Image size 2212x1659; 45° FOV; CFP:
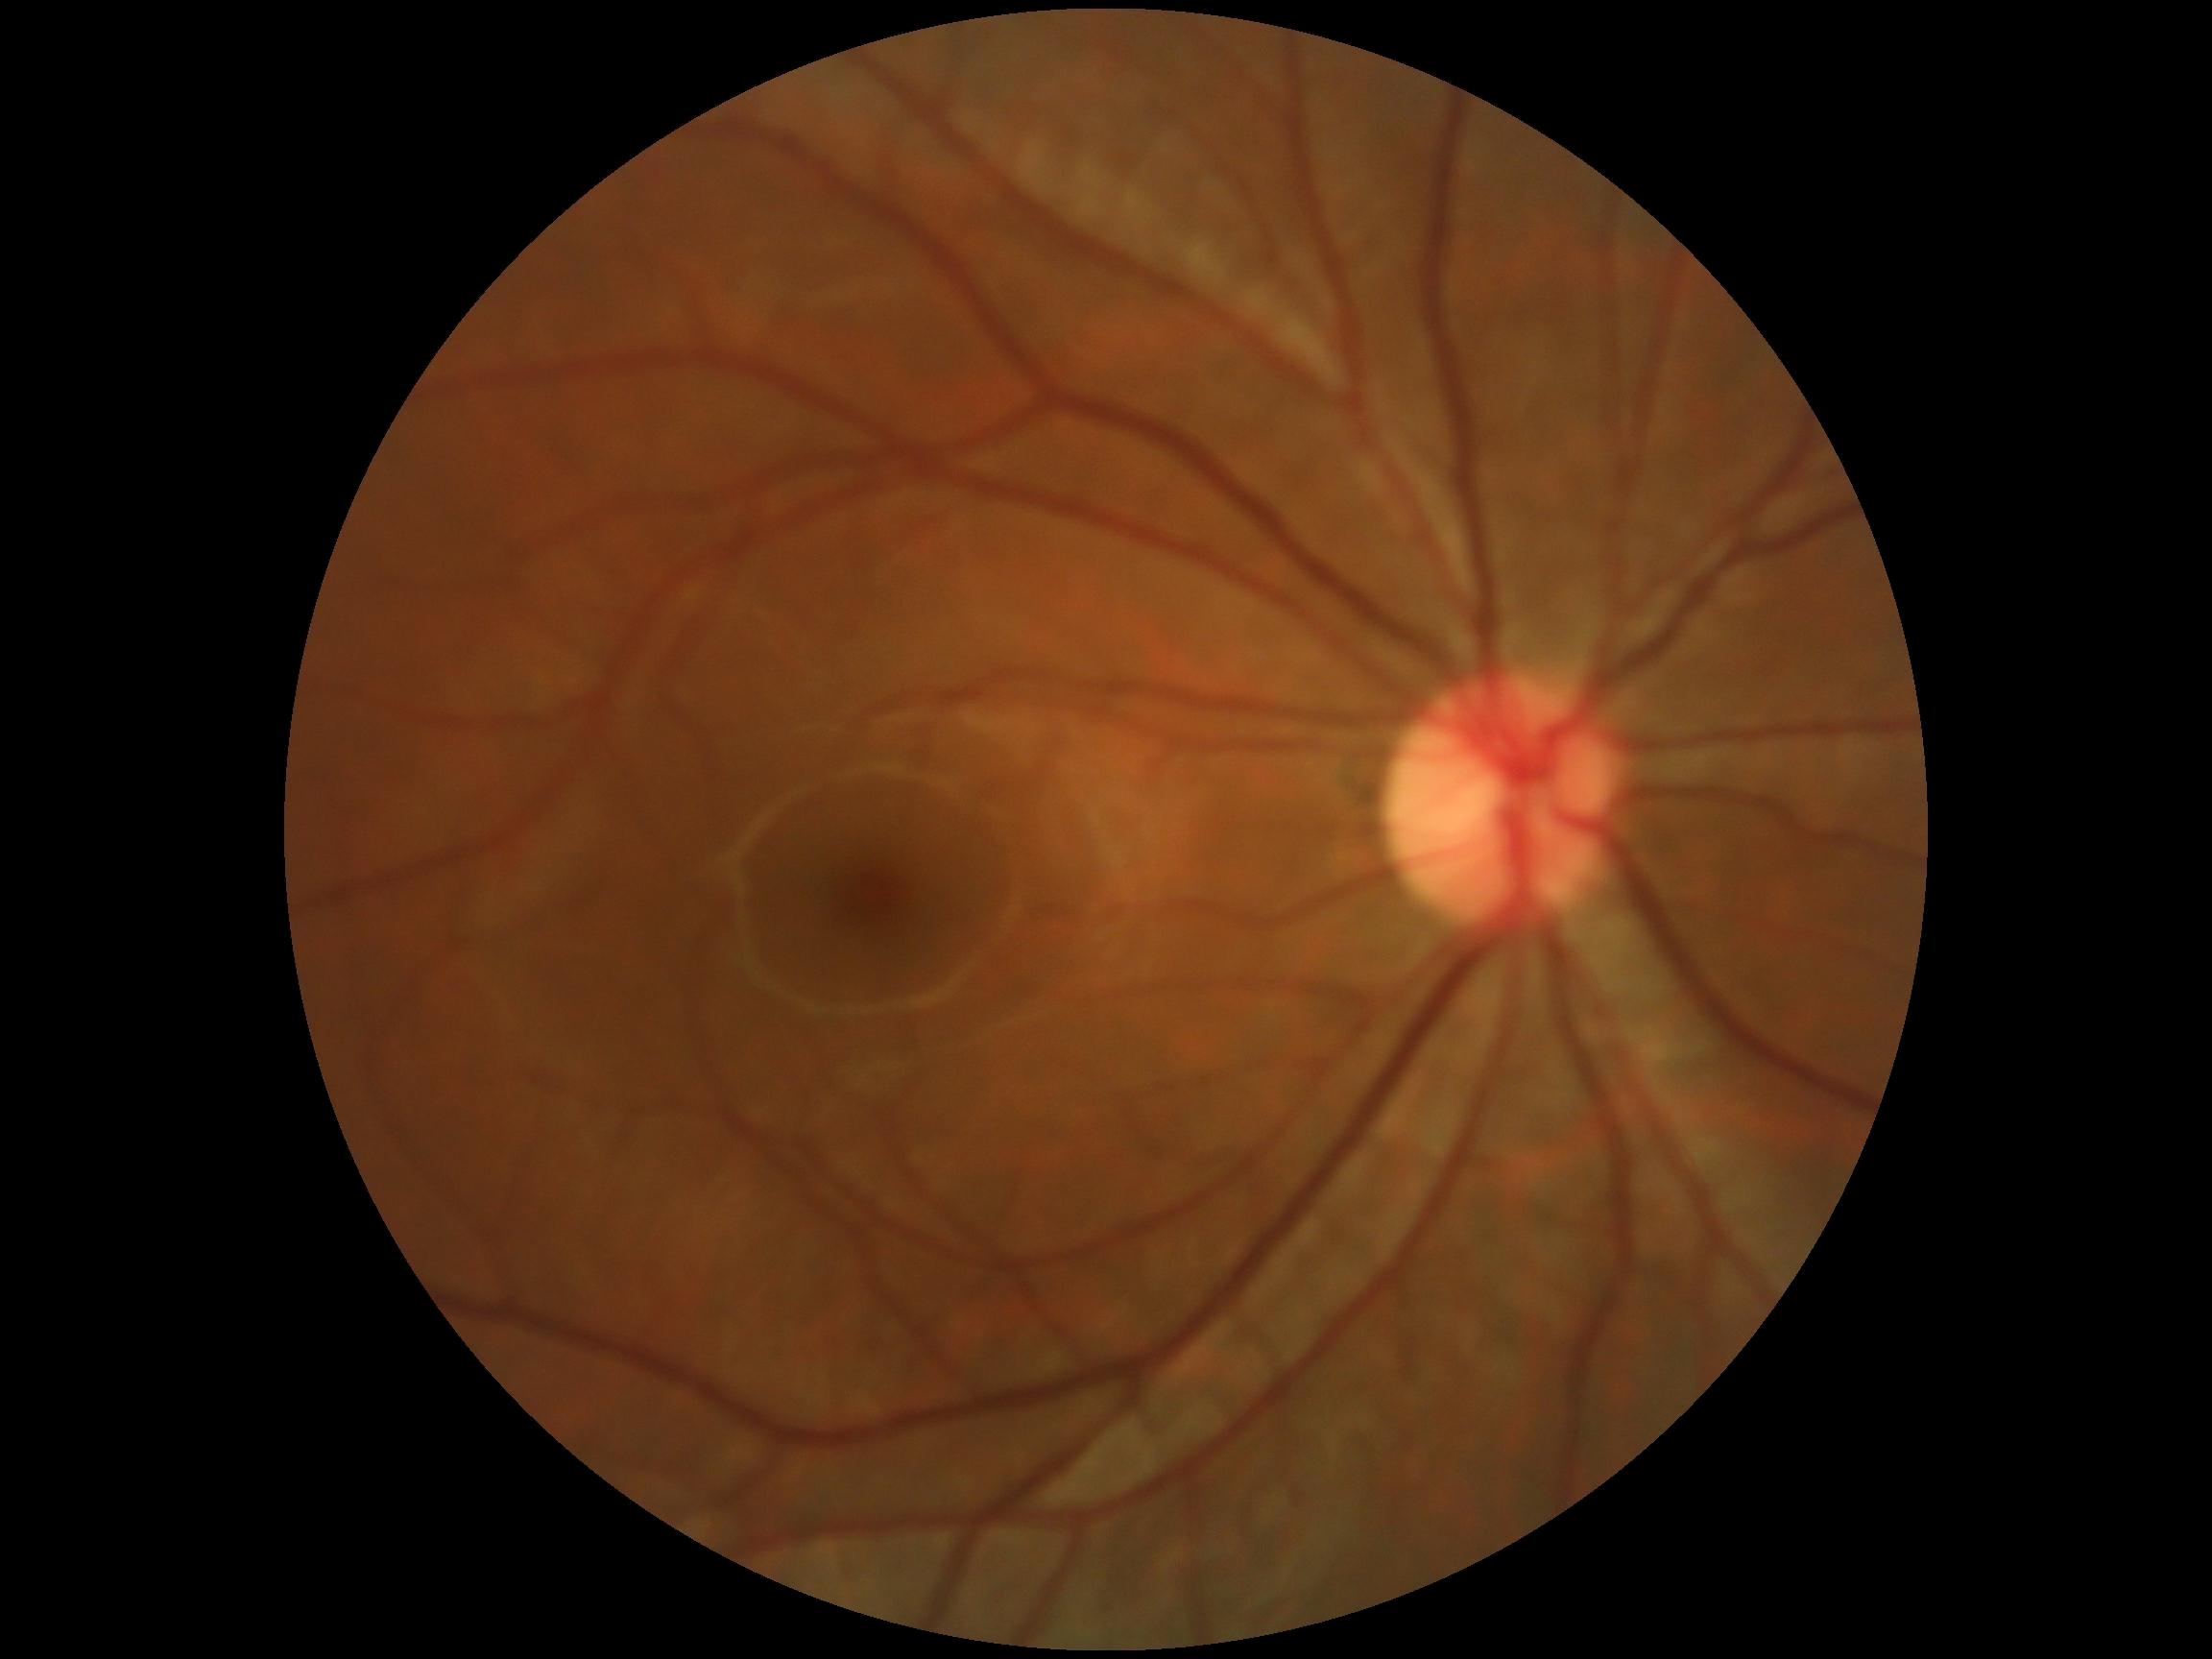 DR grade = 0.